DR severity per modified Davis staging — 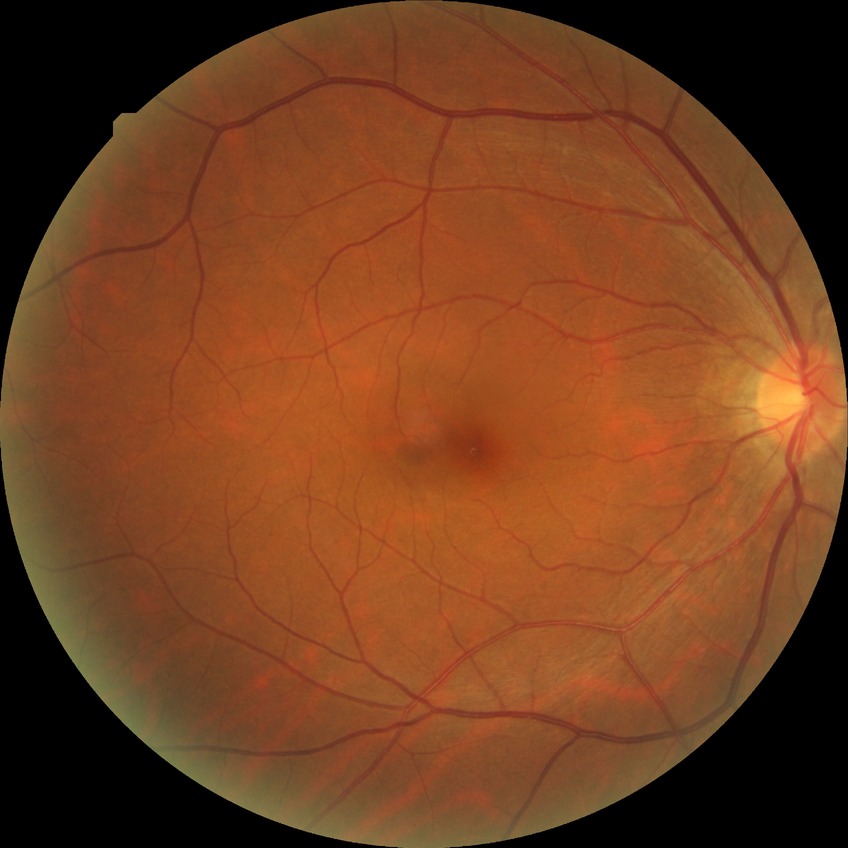 Diabetic retinopathy (DR): no diabetic retinopathy (NDR).